45-degree field of view; image size 1932x1910
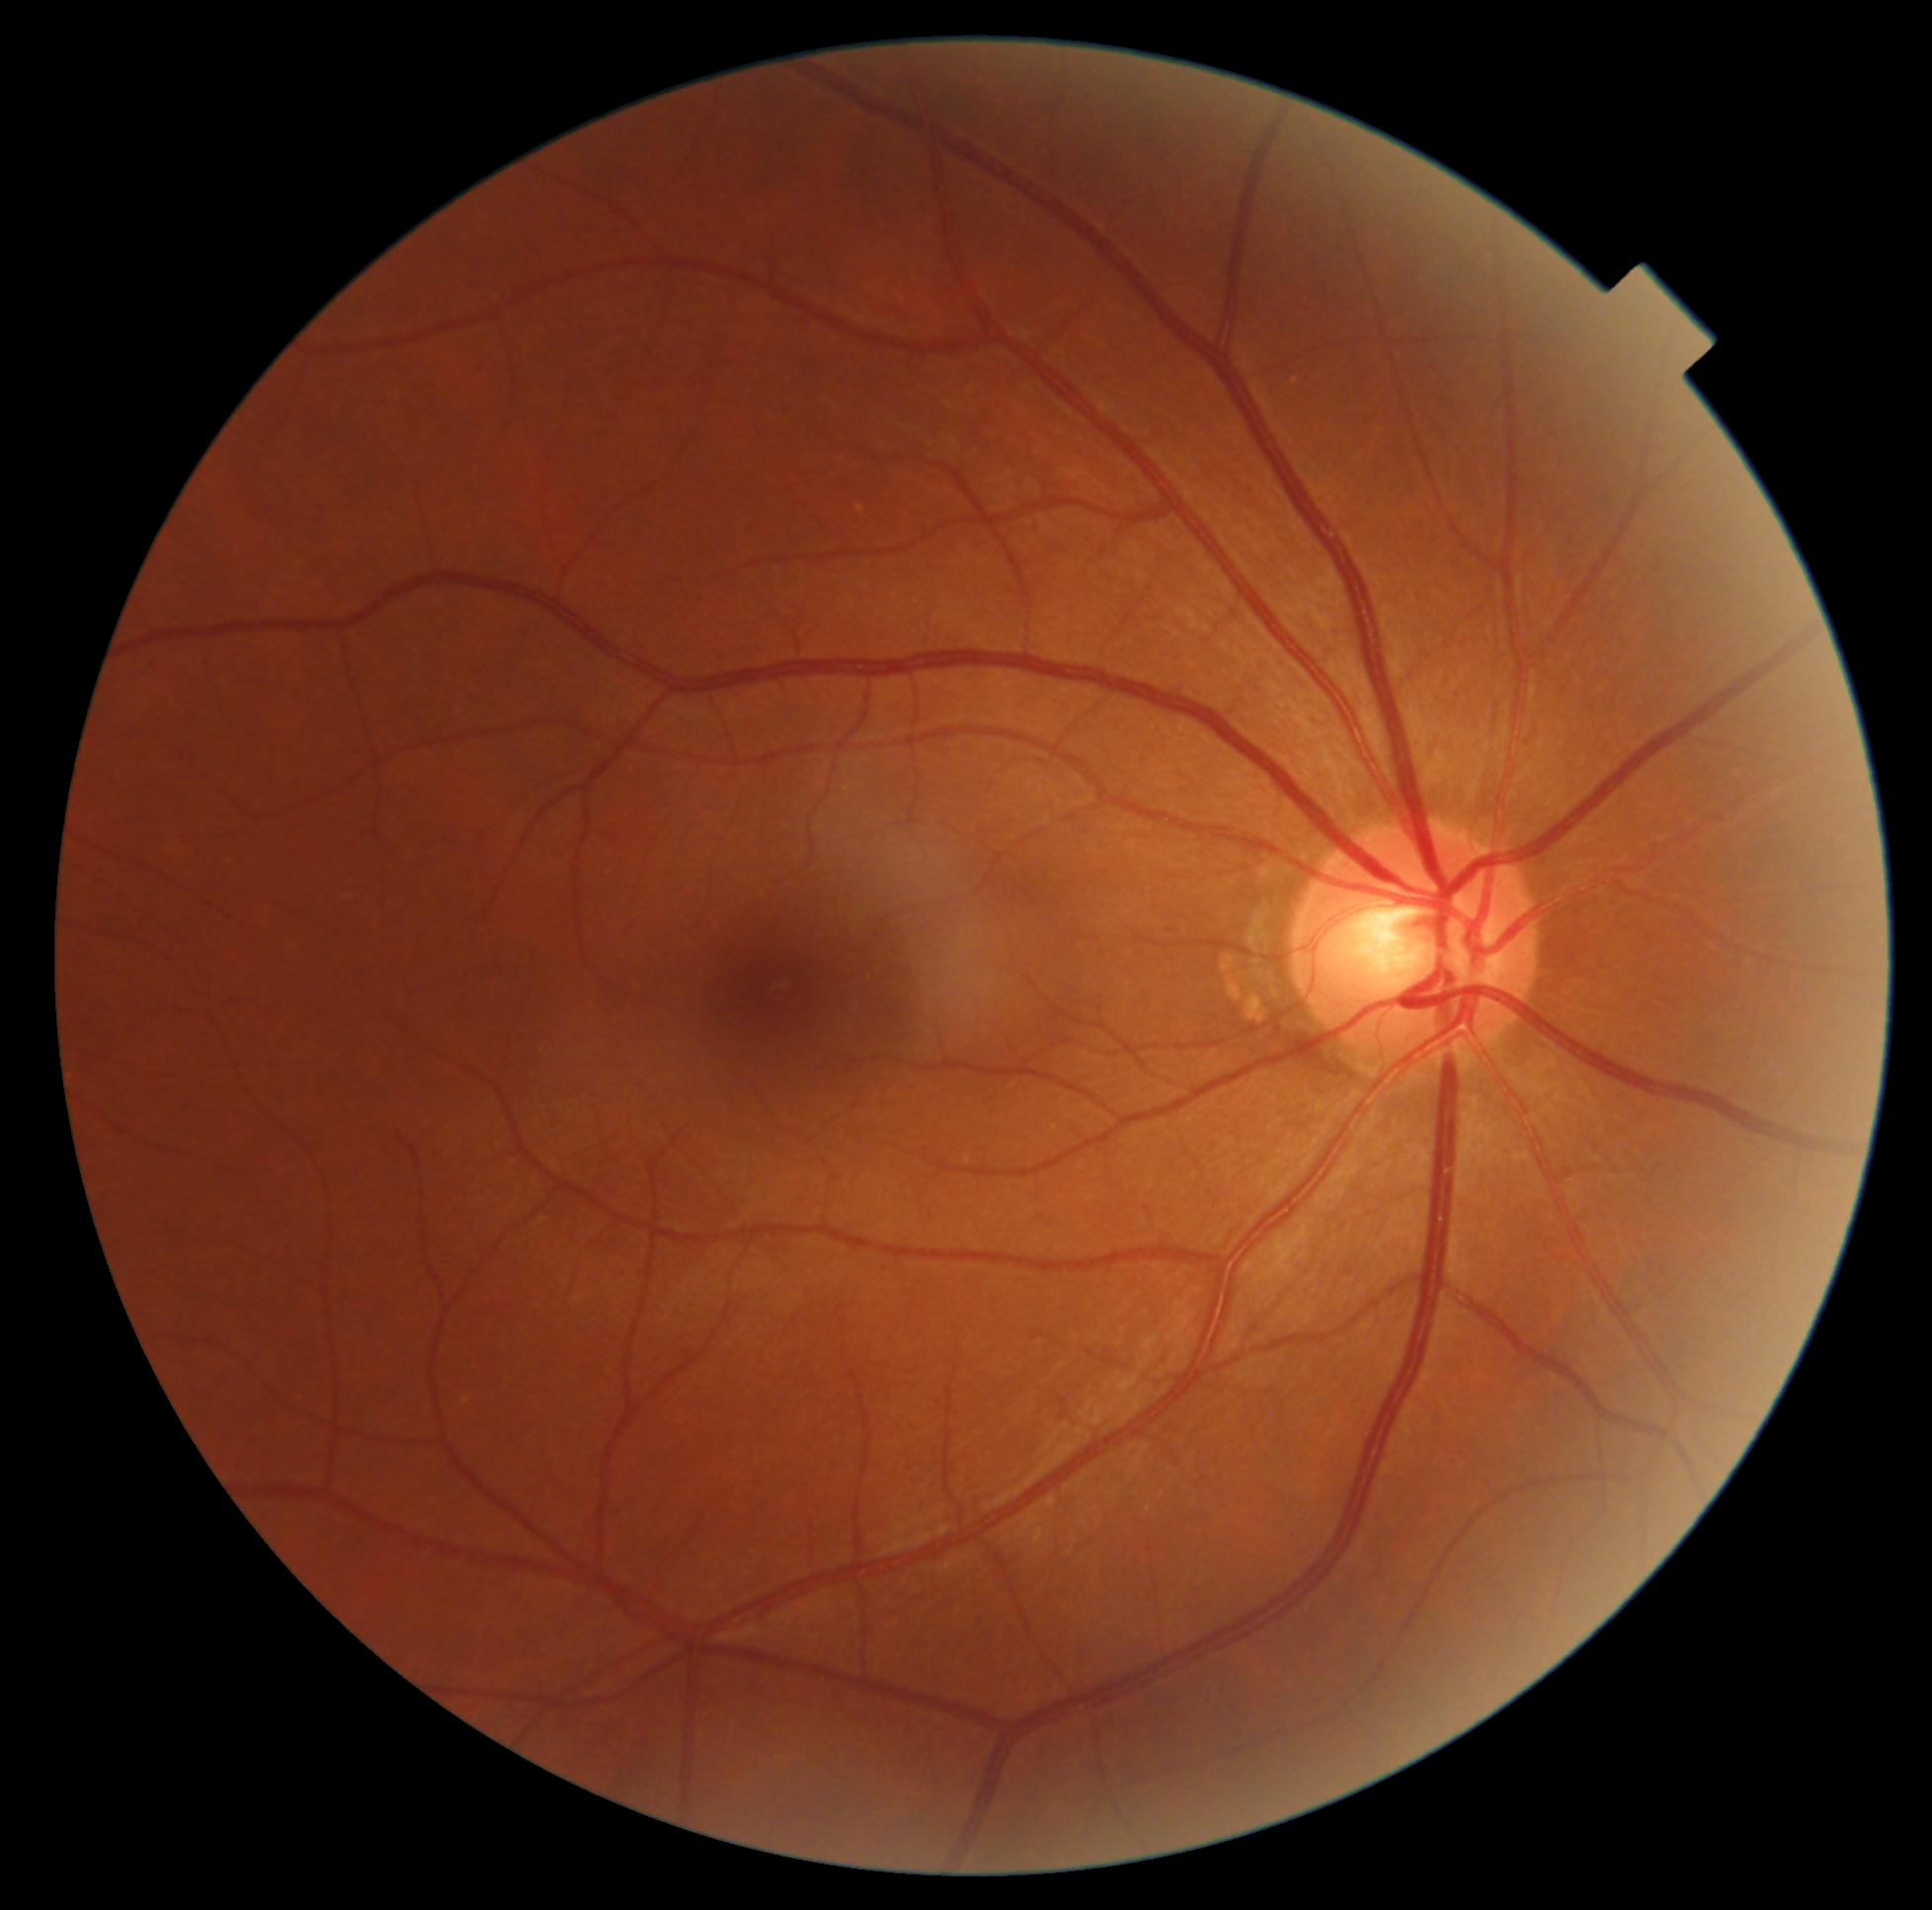   dr_grade: 0